45° field of view
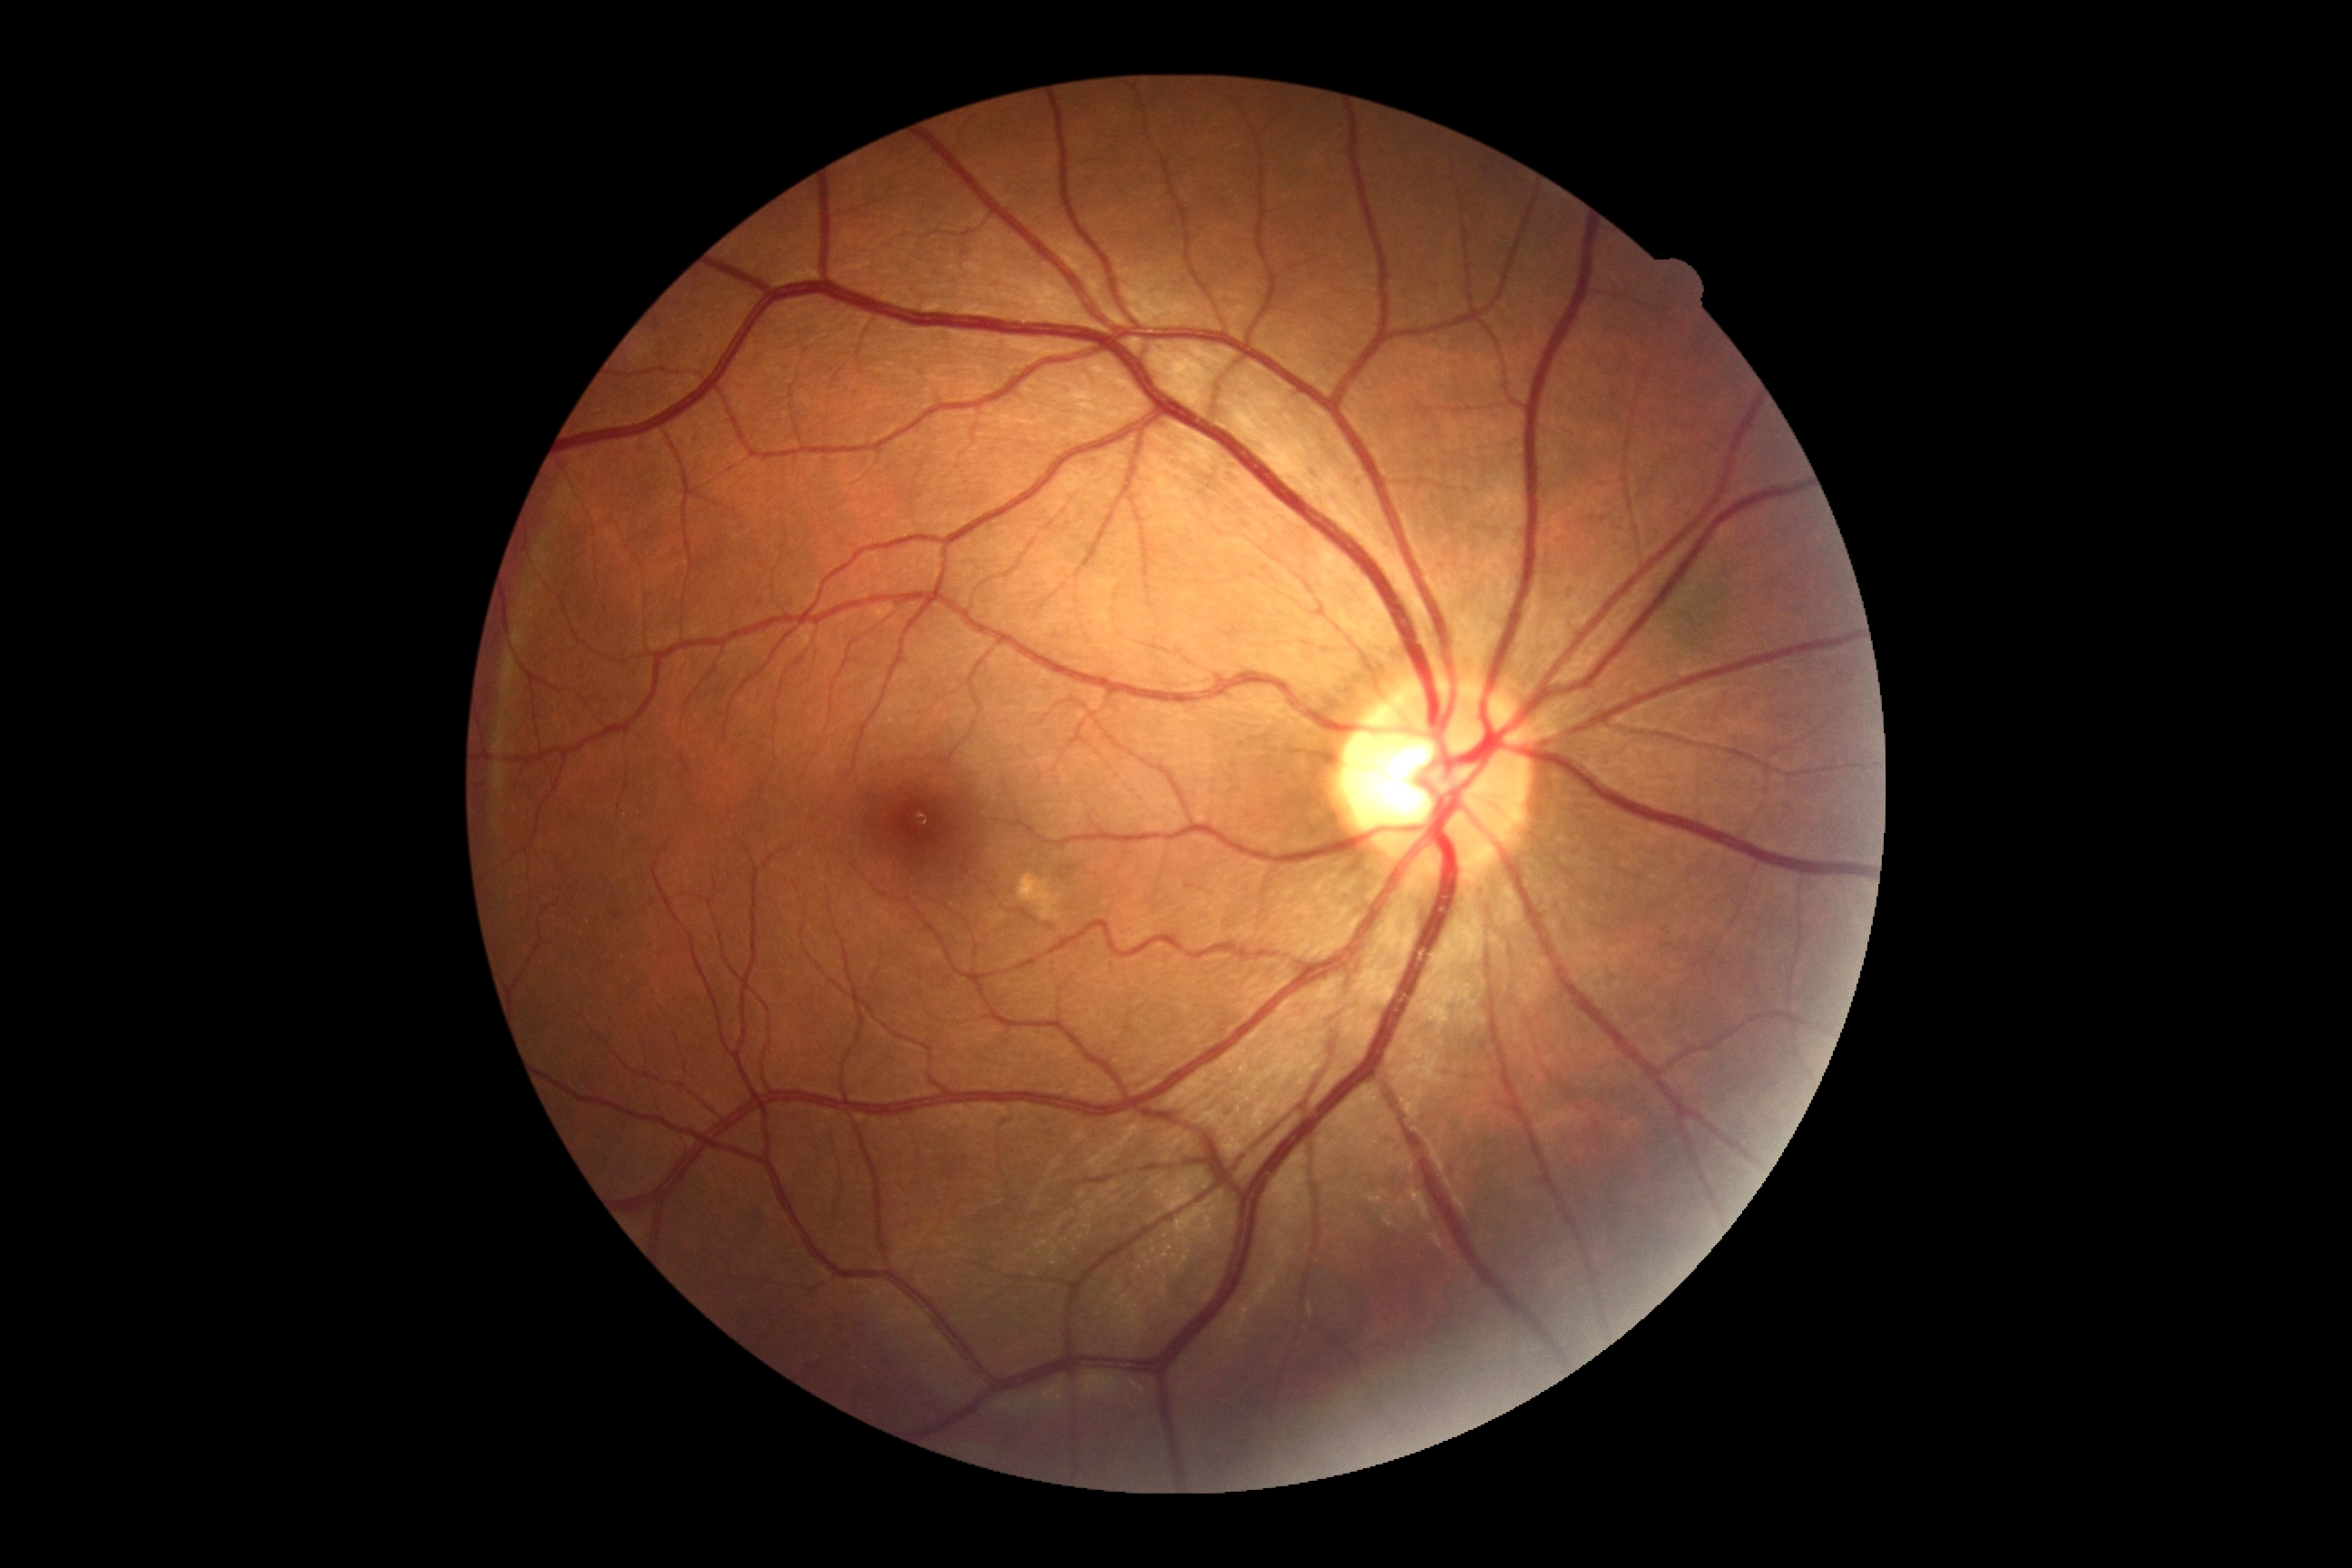
Findings:
- DR stage — 0/4
- DR impression — negative for DR